Modified Davis grading; fundus photo; nonmydriatic; 848 by 848 pixels; 45-degree field of view
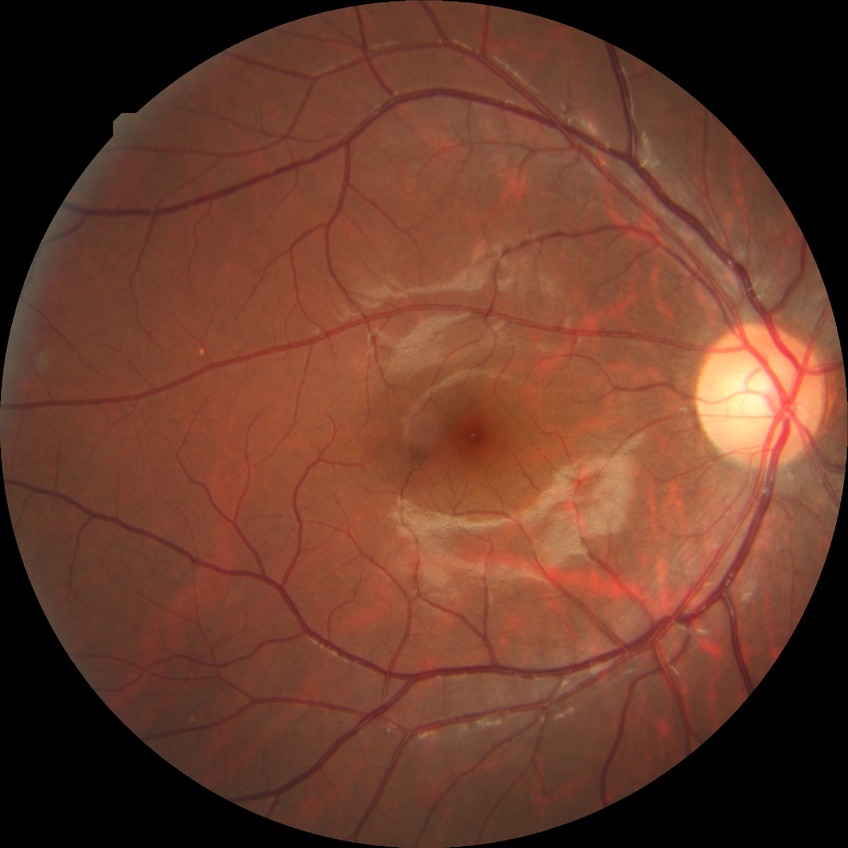 {"dr_impression": "no DR findings", "davis_grade": "NDR"}